Image size 848x848. 45 degree fundus photograph. Retinal fundus photograph. NIDEK AFC-230 fundus camera: 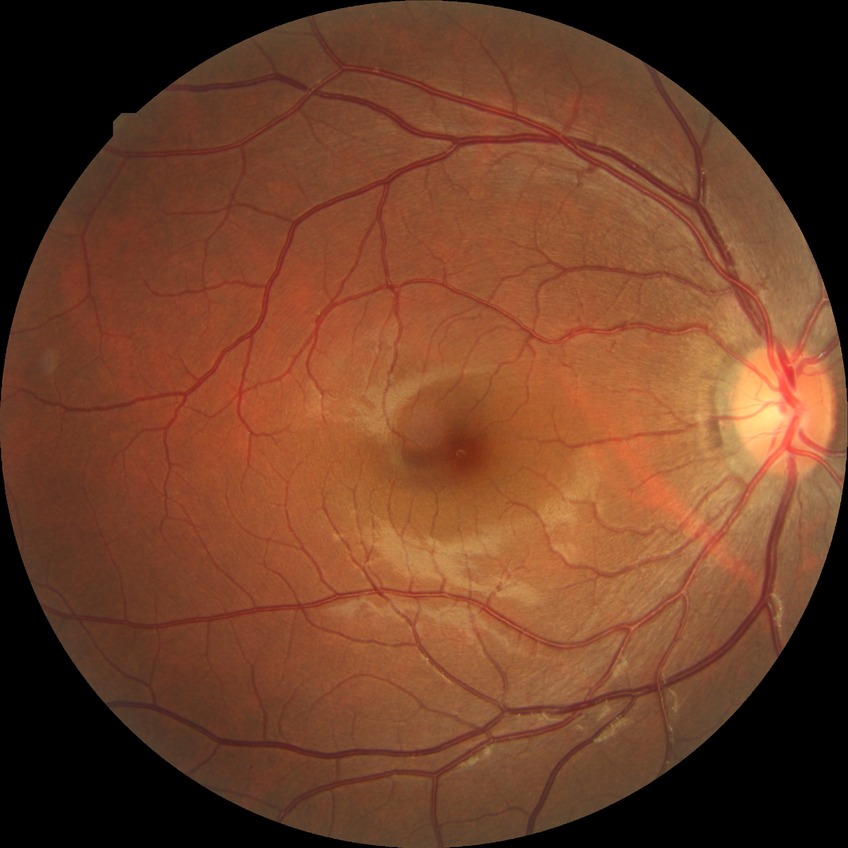

DR impression = no signs of DR; DR = NDR.